Color fundus image.
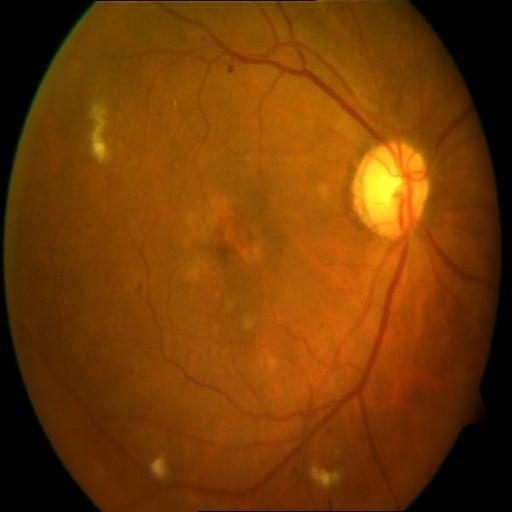 Diagnosis: HR (hemorrhagic retinopathy); ODC (optic disc cupping).